Camera: Phoenix ICON (100° FOV) · pediatric retinal photograph (wide-field) — 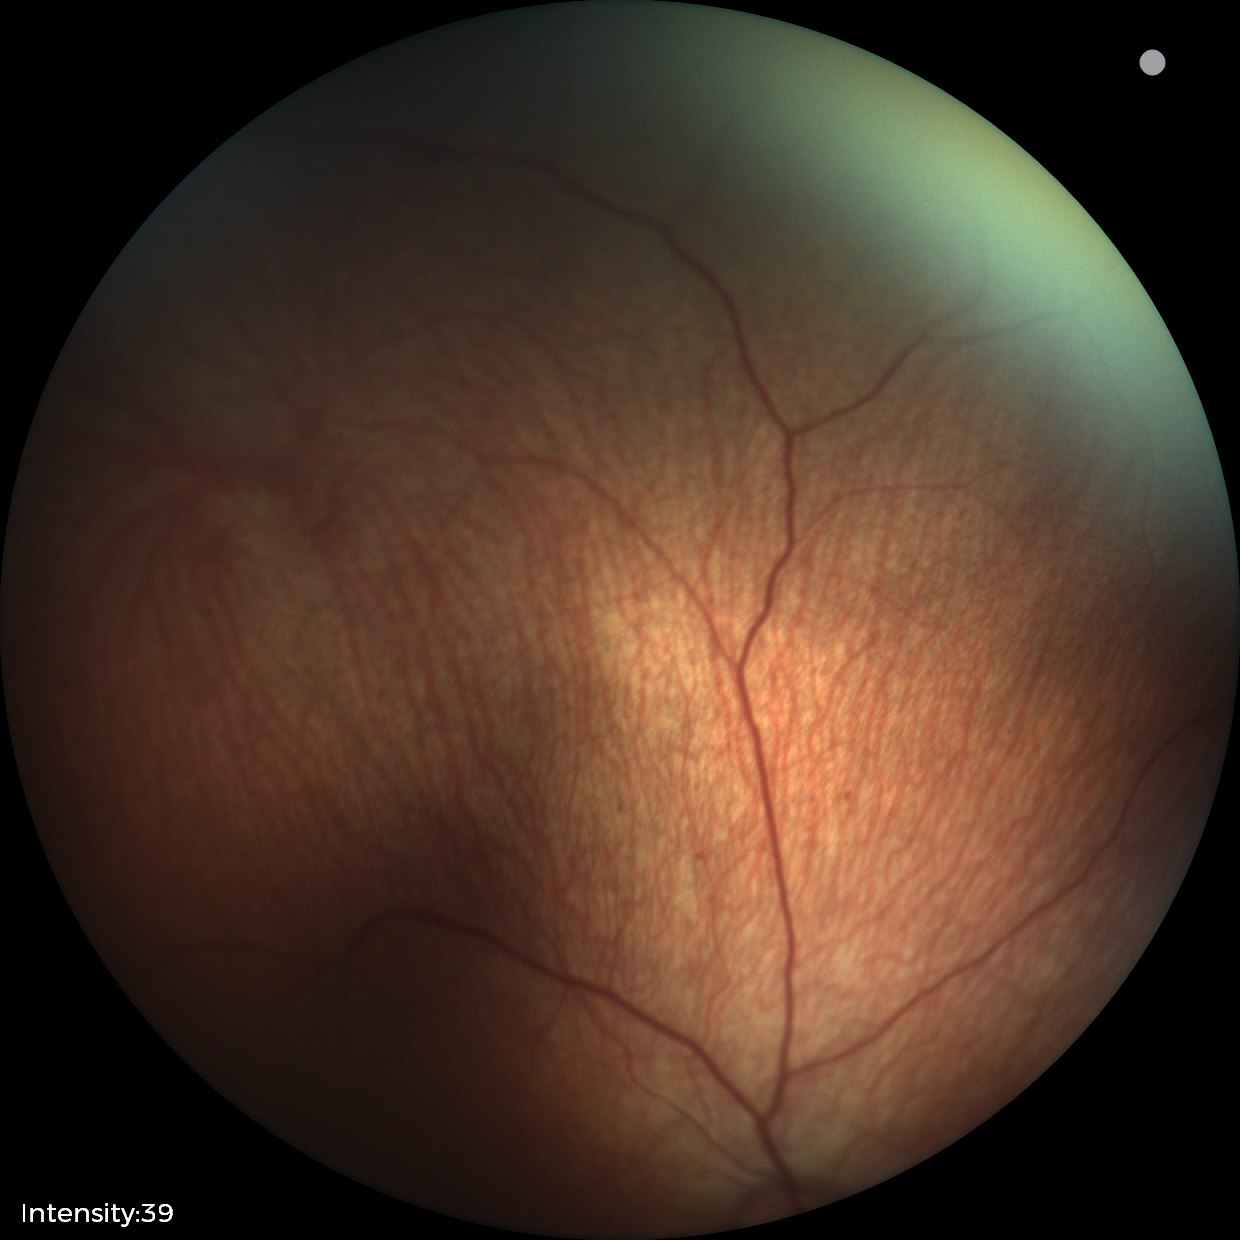

Q: What is the diagnosis from this examination?
A: physiological retinal finding